Pediatric wide-field fundus photograph: 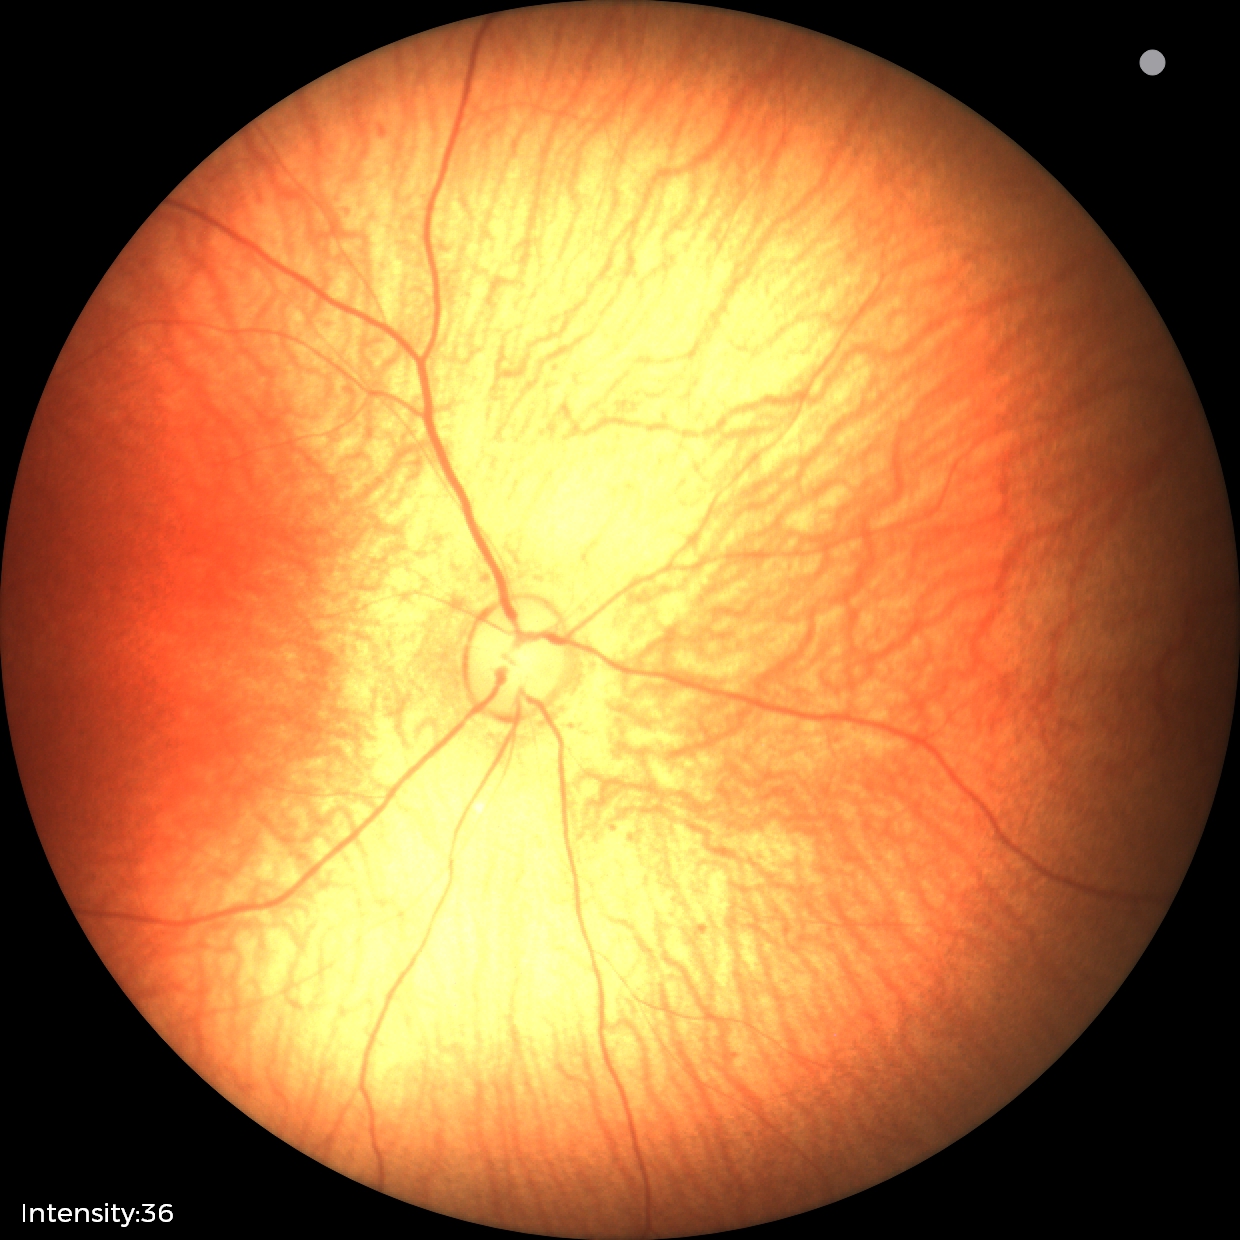

Q: What is the screening diagnosis?
A: physiological retinal finding